2361x1568 · captured after pupil dilation · color fundus photograph · 50° field of view · macula-centered: 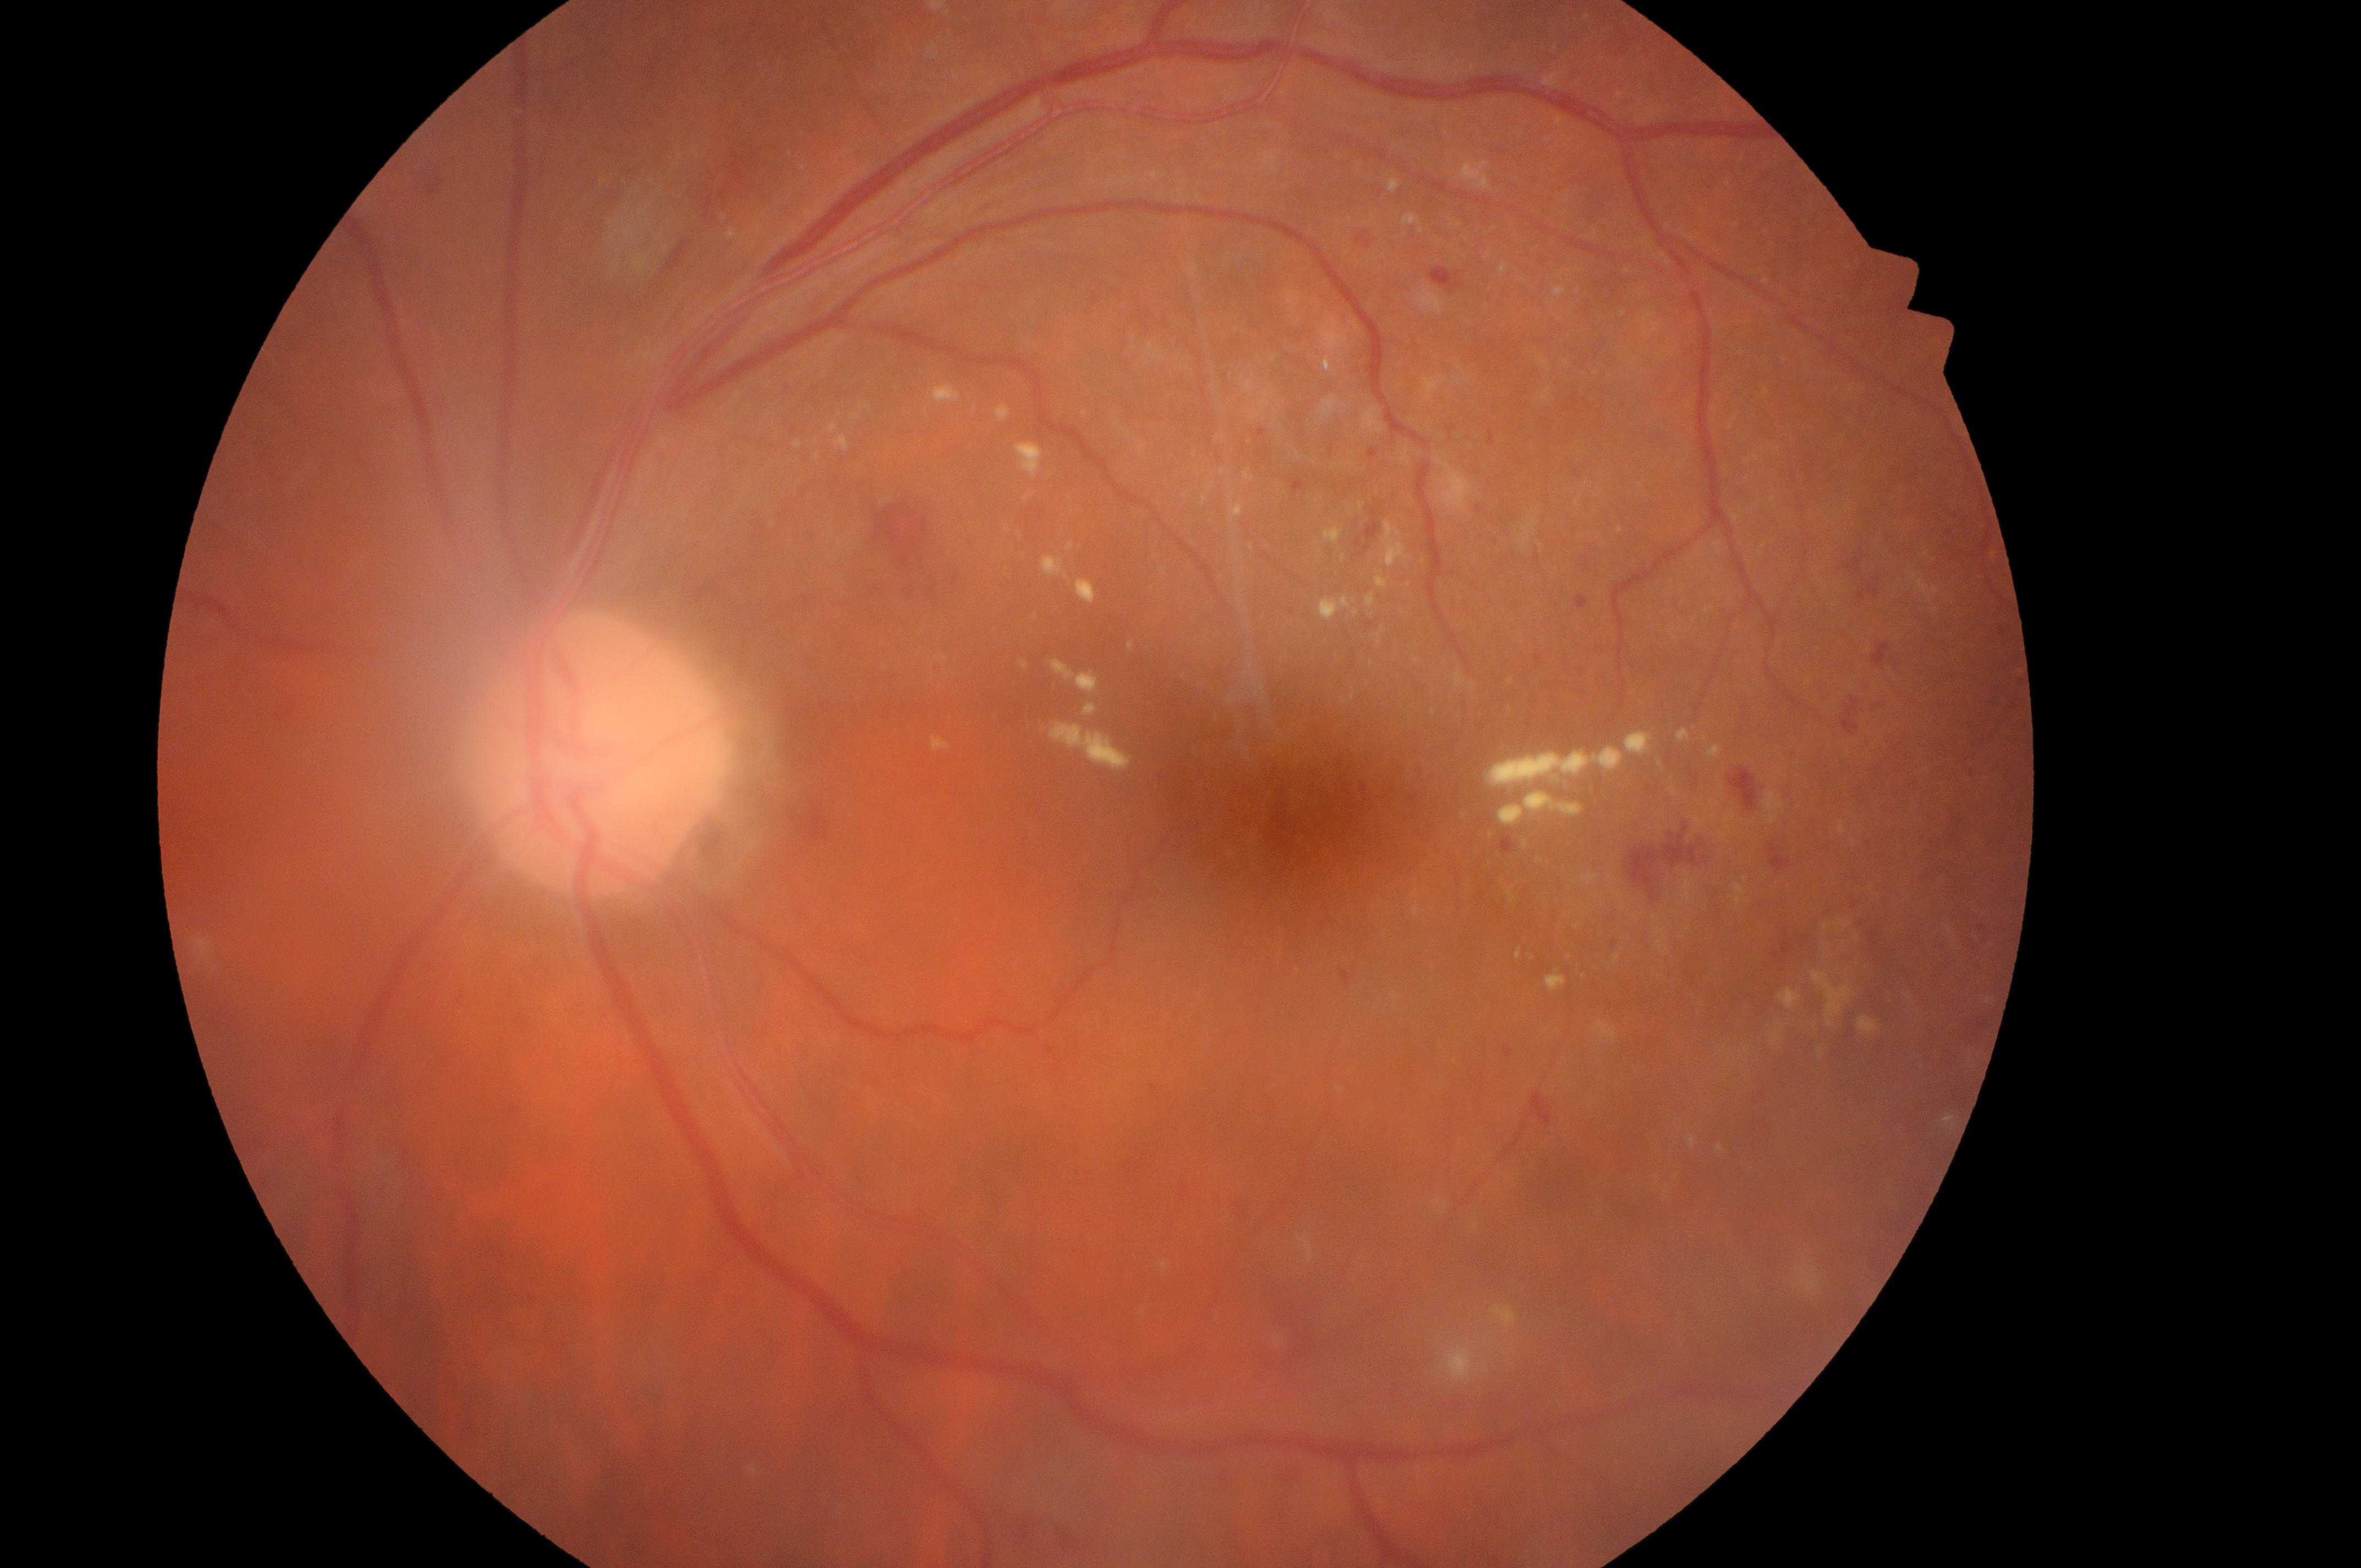
  dr_grade: 2
  eye: left eye
  optic_disc: x=590, y=765
  fovea: x=1295, y=823
  dme_grade: 2